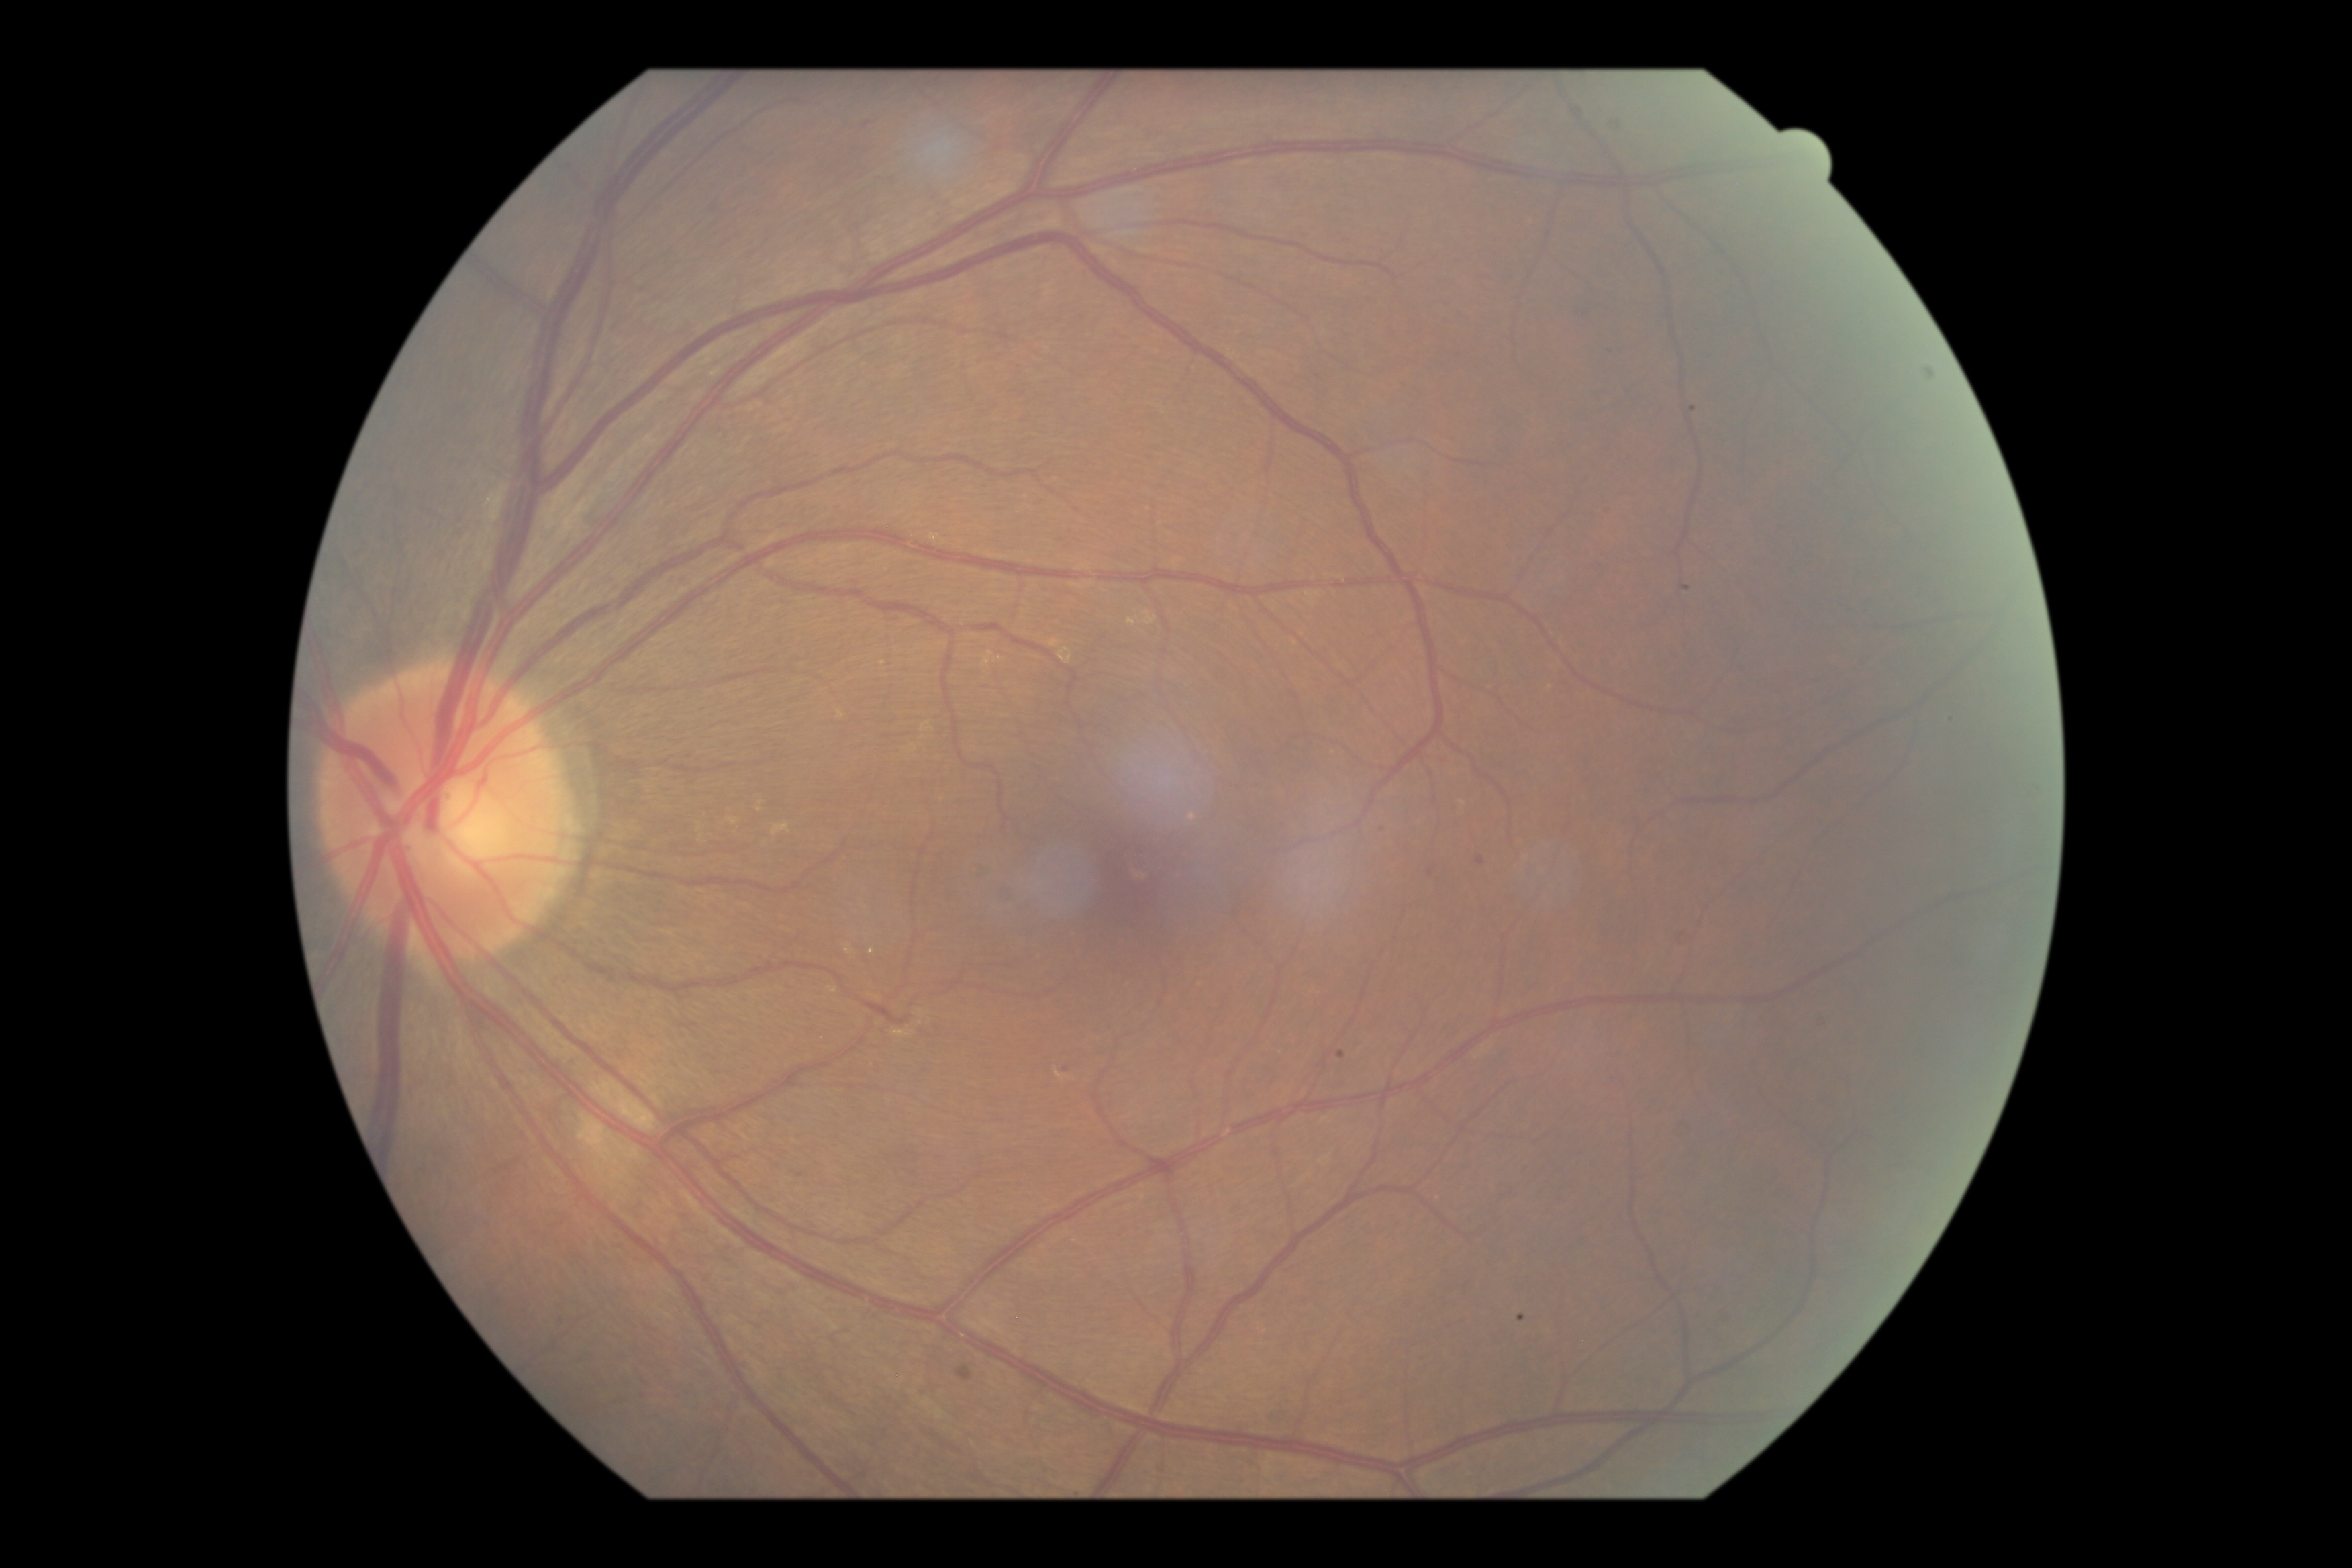
Diabetic retinopathy (DR): mild non-proliferative diabetic retinopathy (grade 1).